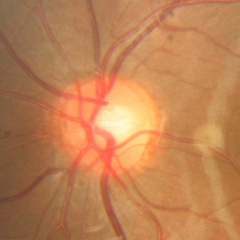
No signs of glaucoma.